45° field of view; 2352 x 1568 pixels: 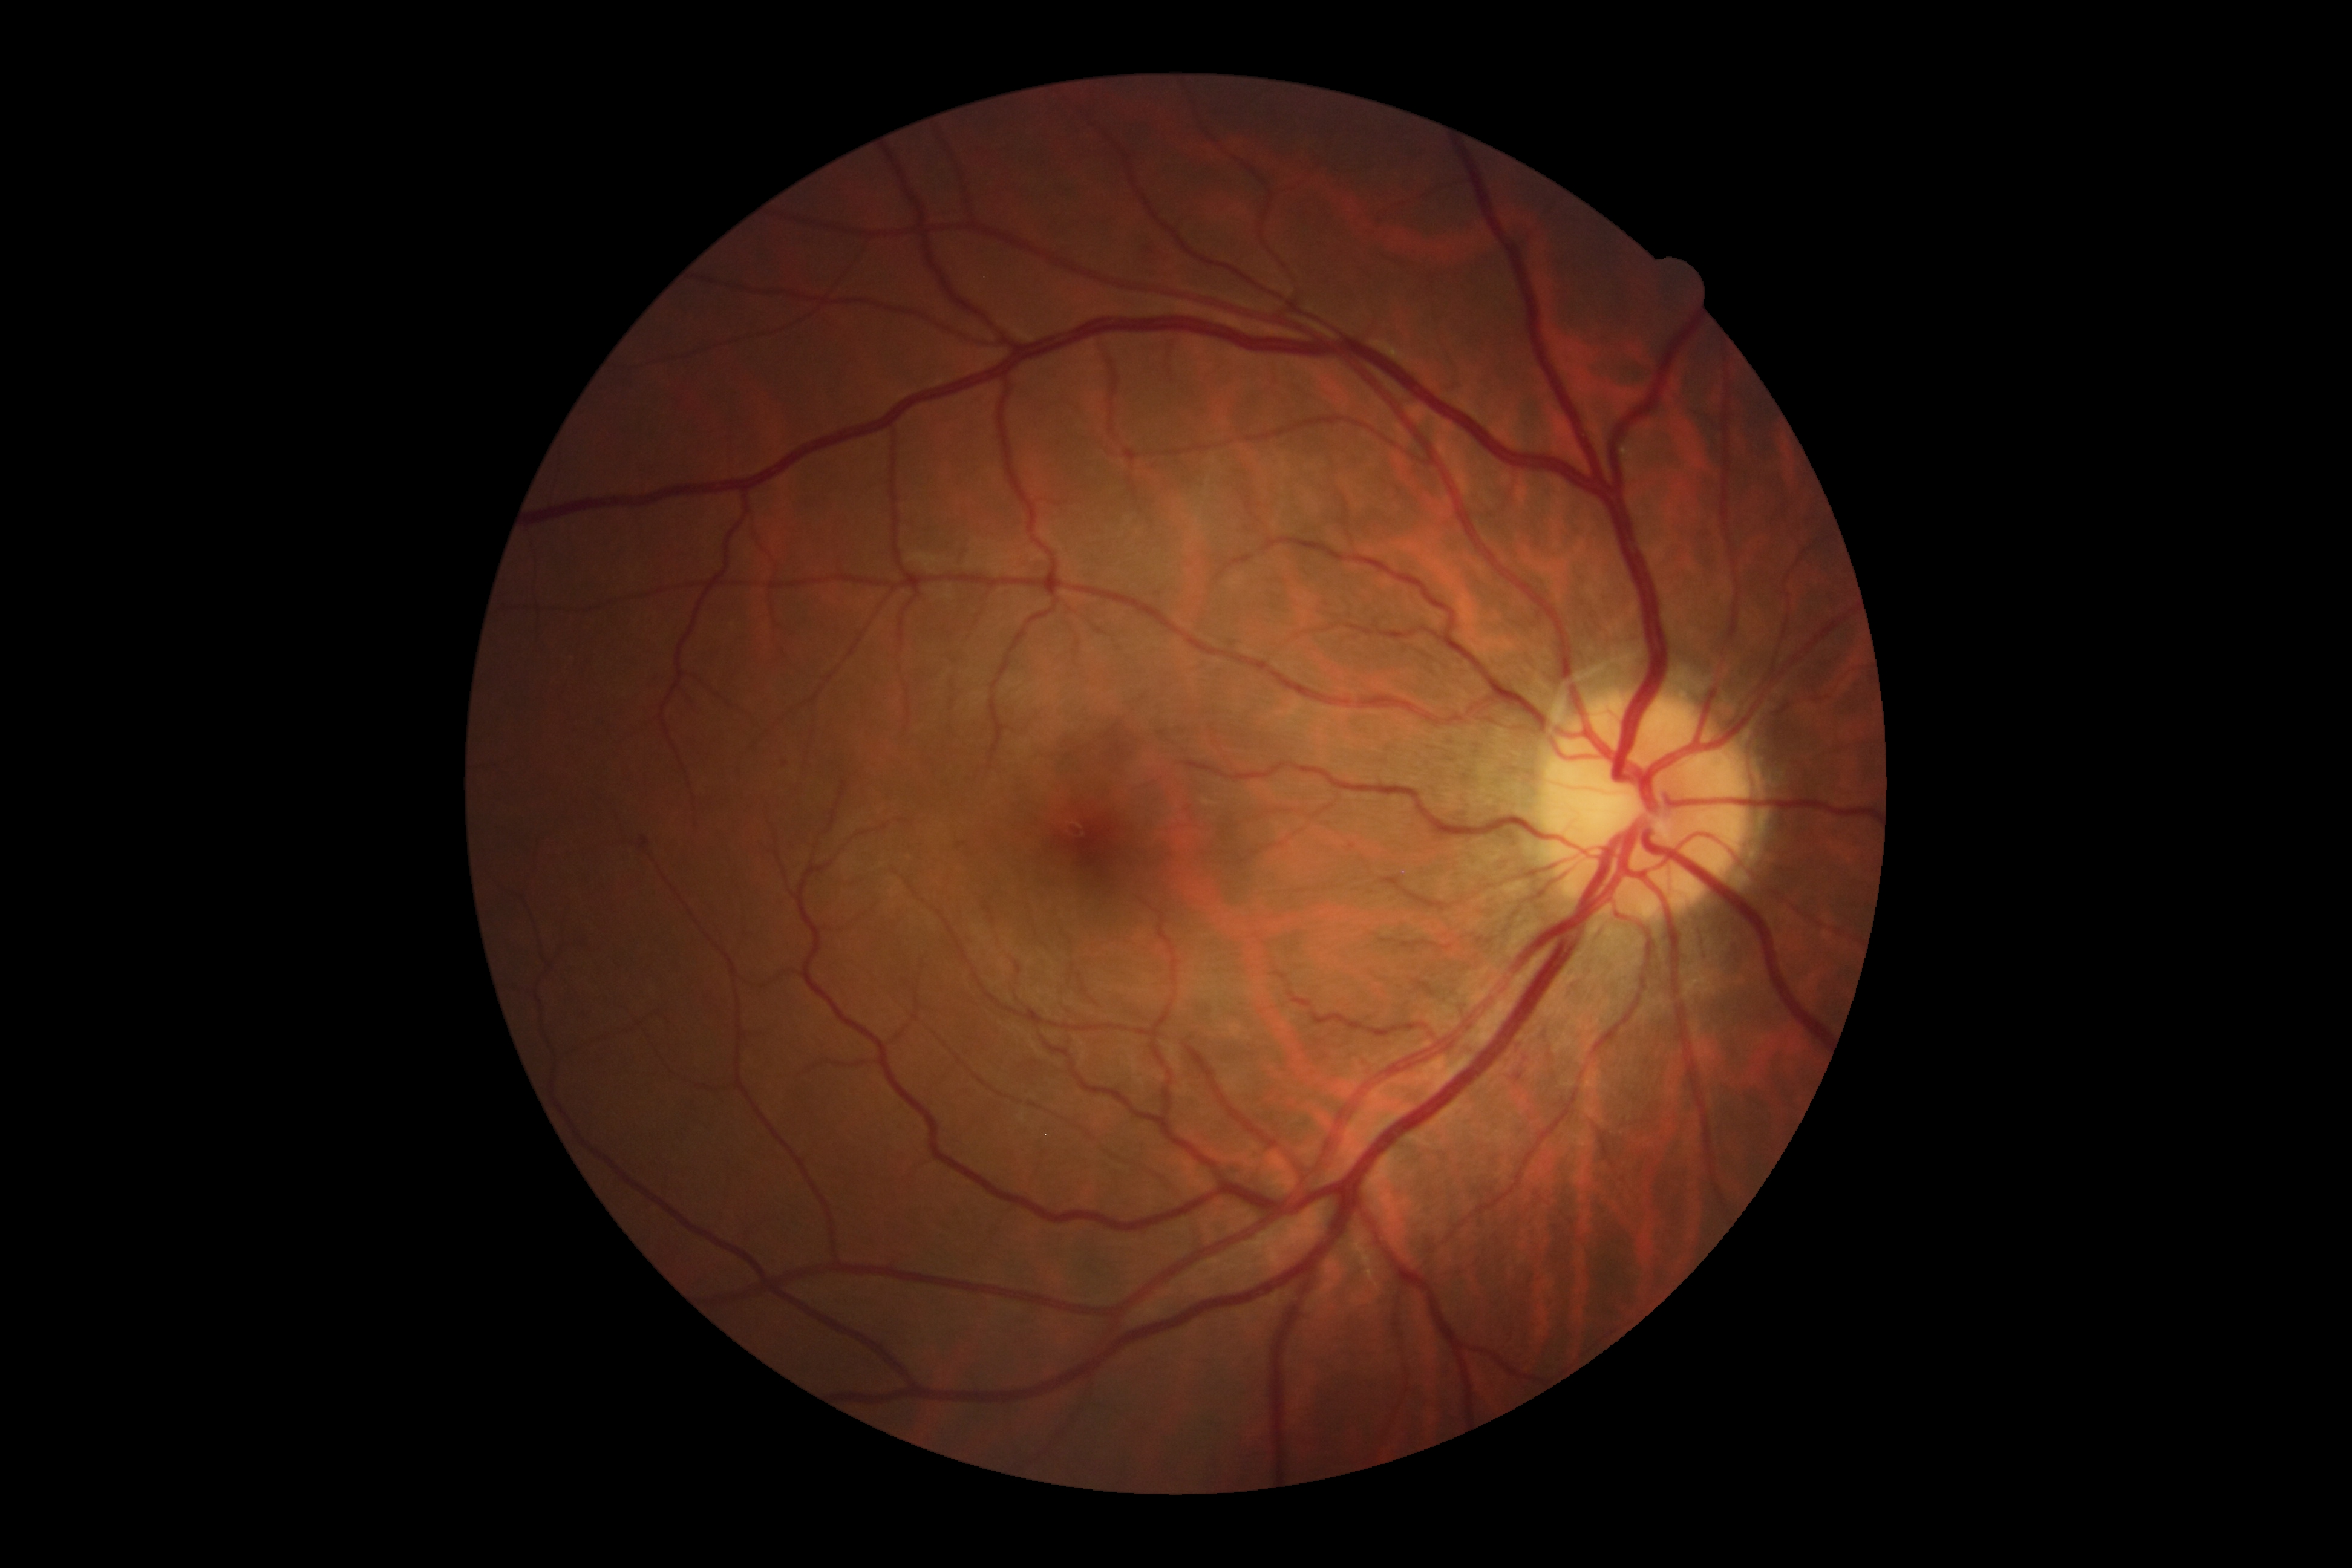
DR: moderate NPDR (grade 2).